848x848; no pharmacologic dilation: 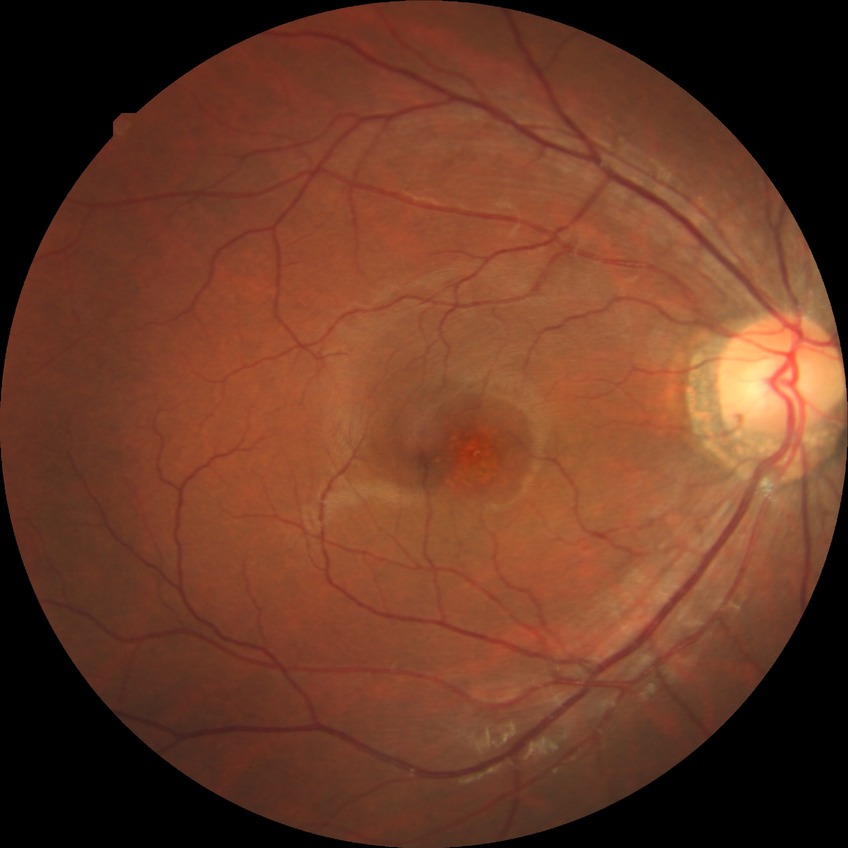
Diabetic retinopathy (DR): NDR (no diabetic retinopathy).